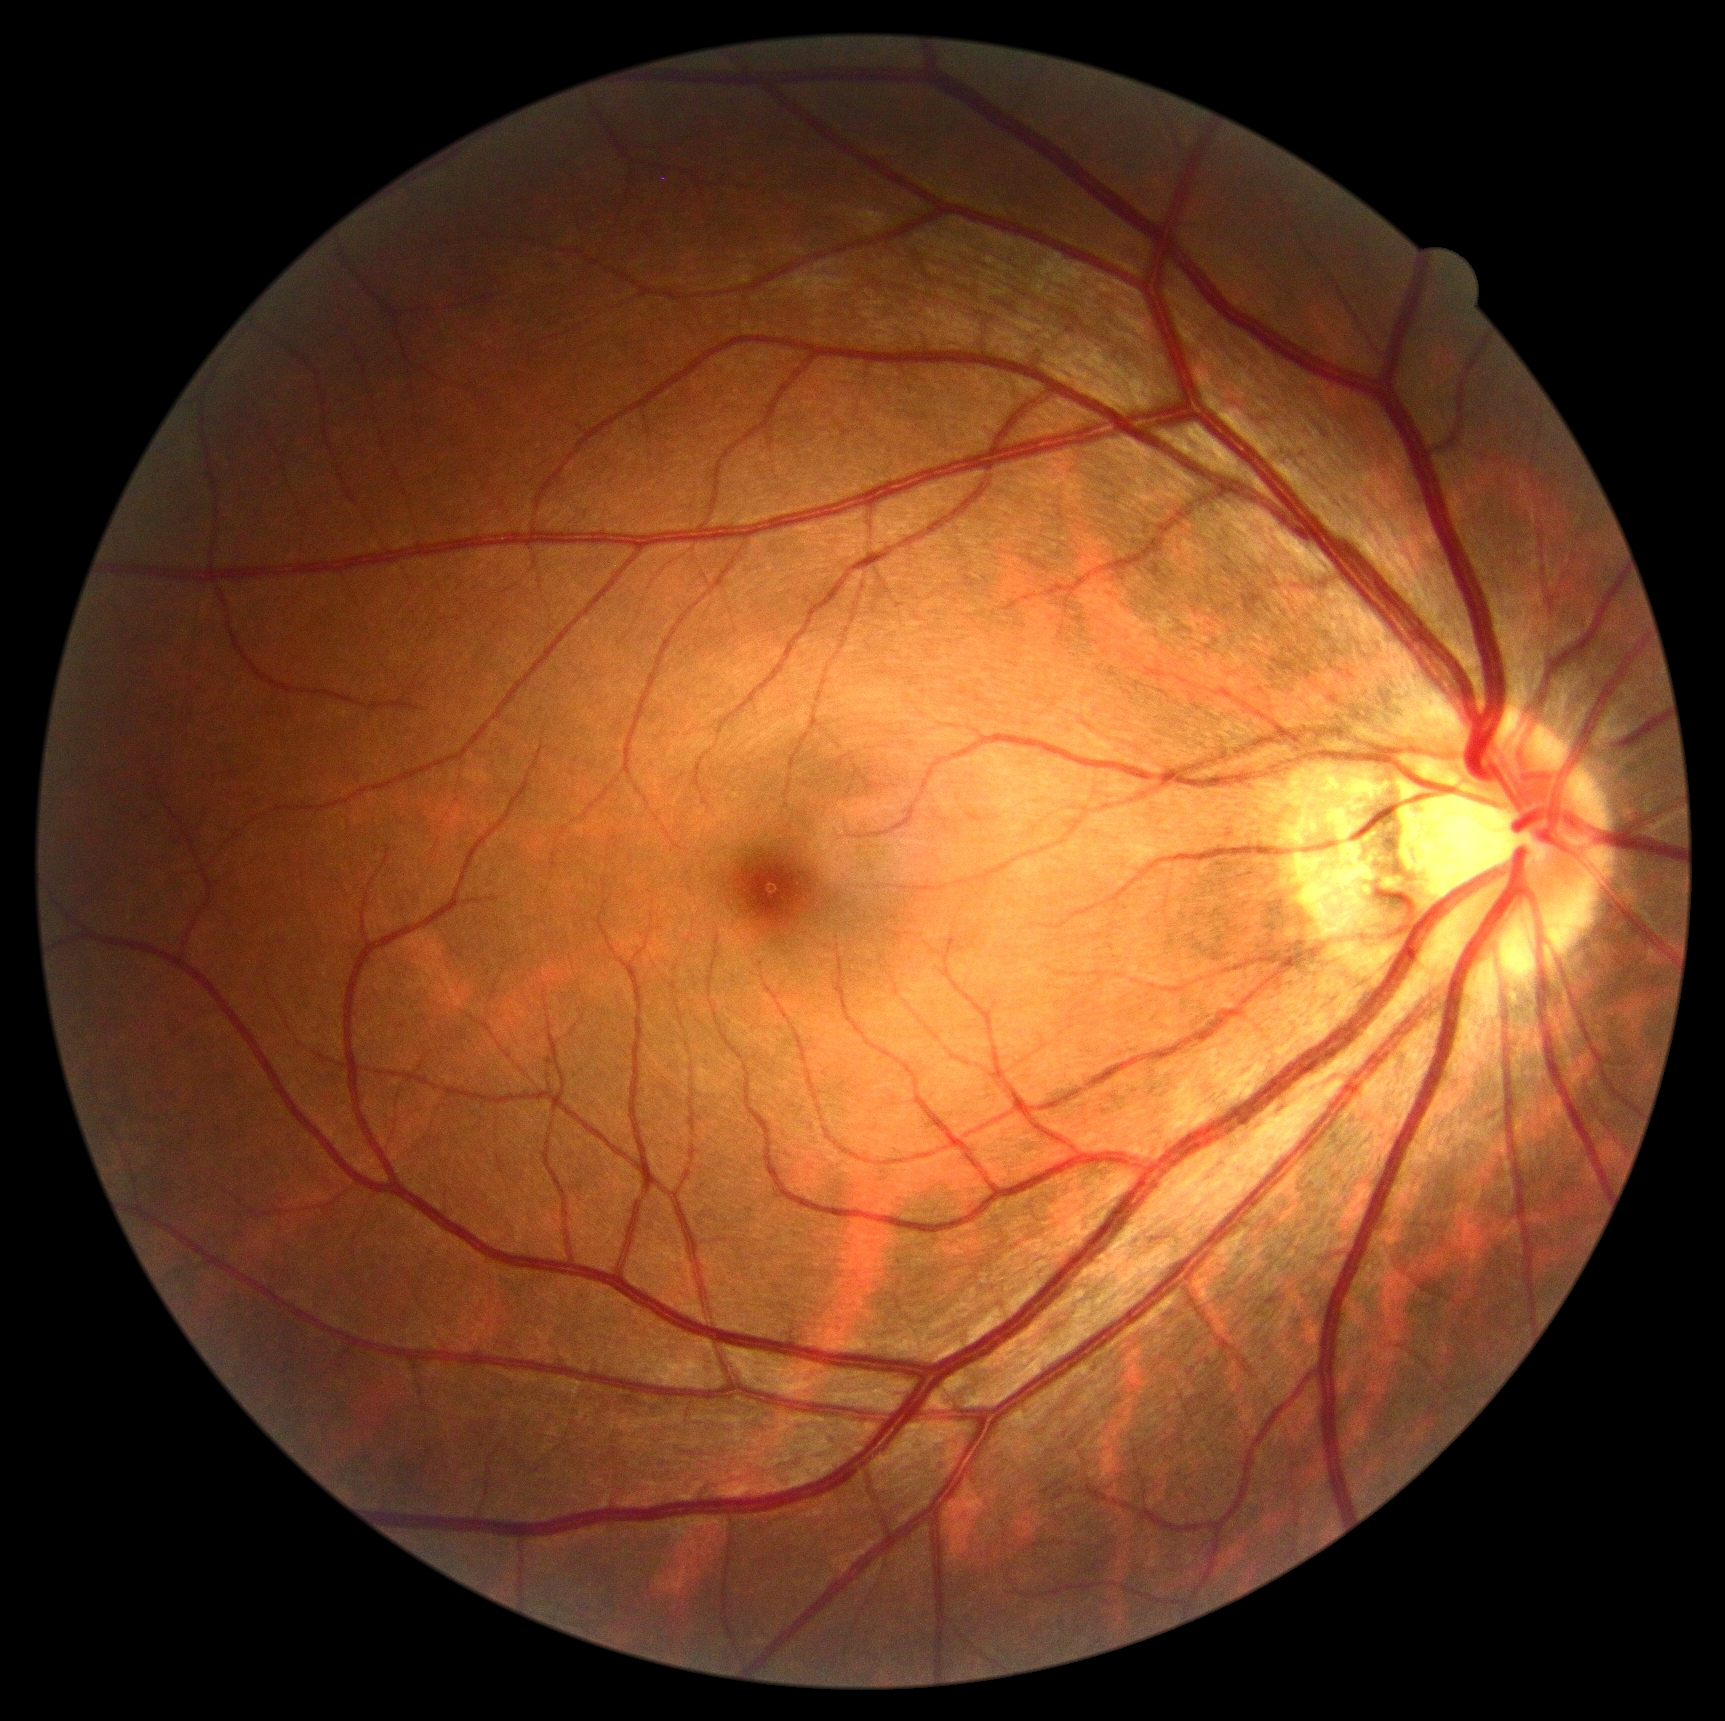

DR grade: 0 (no apparent retinopathy) — no visible signs of diabetic retinopathy. No signs of diabetic retinopathy.